Color fundus image; 2212 by 1659 pixels
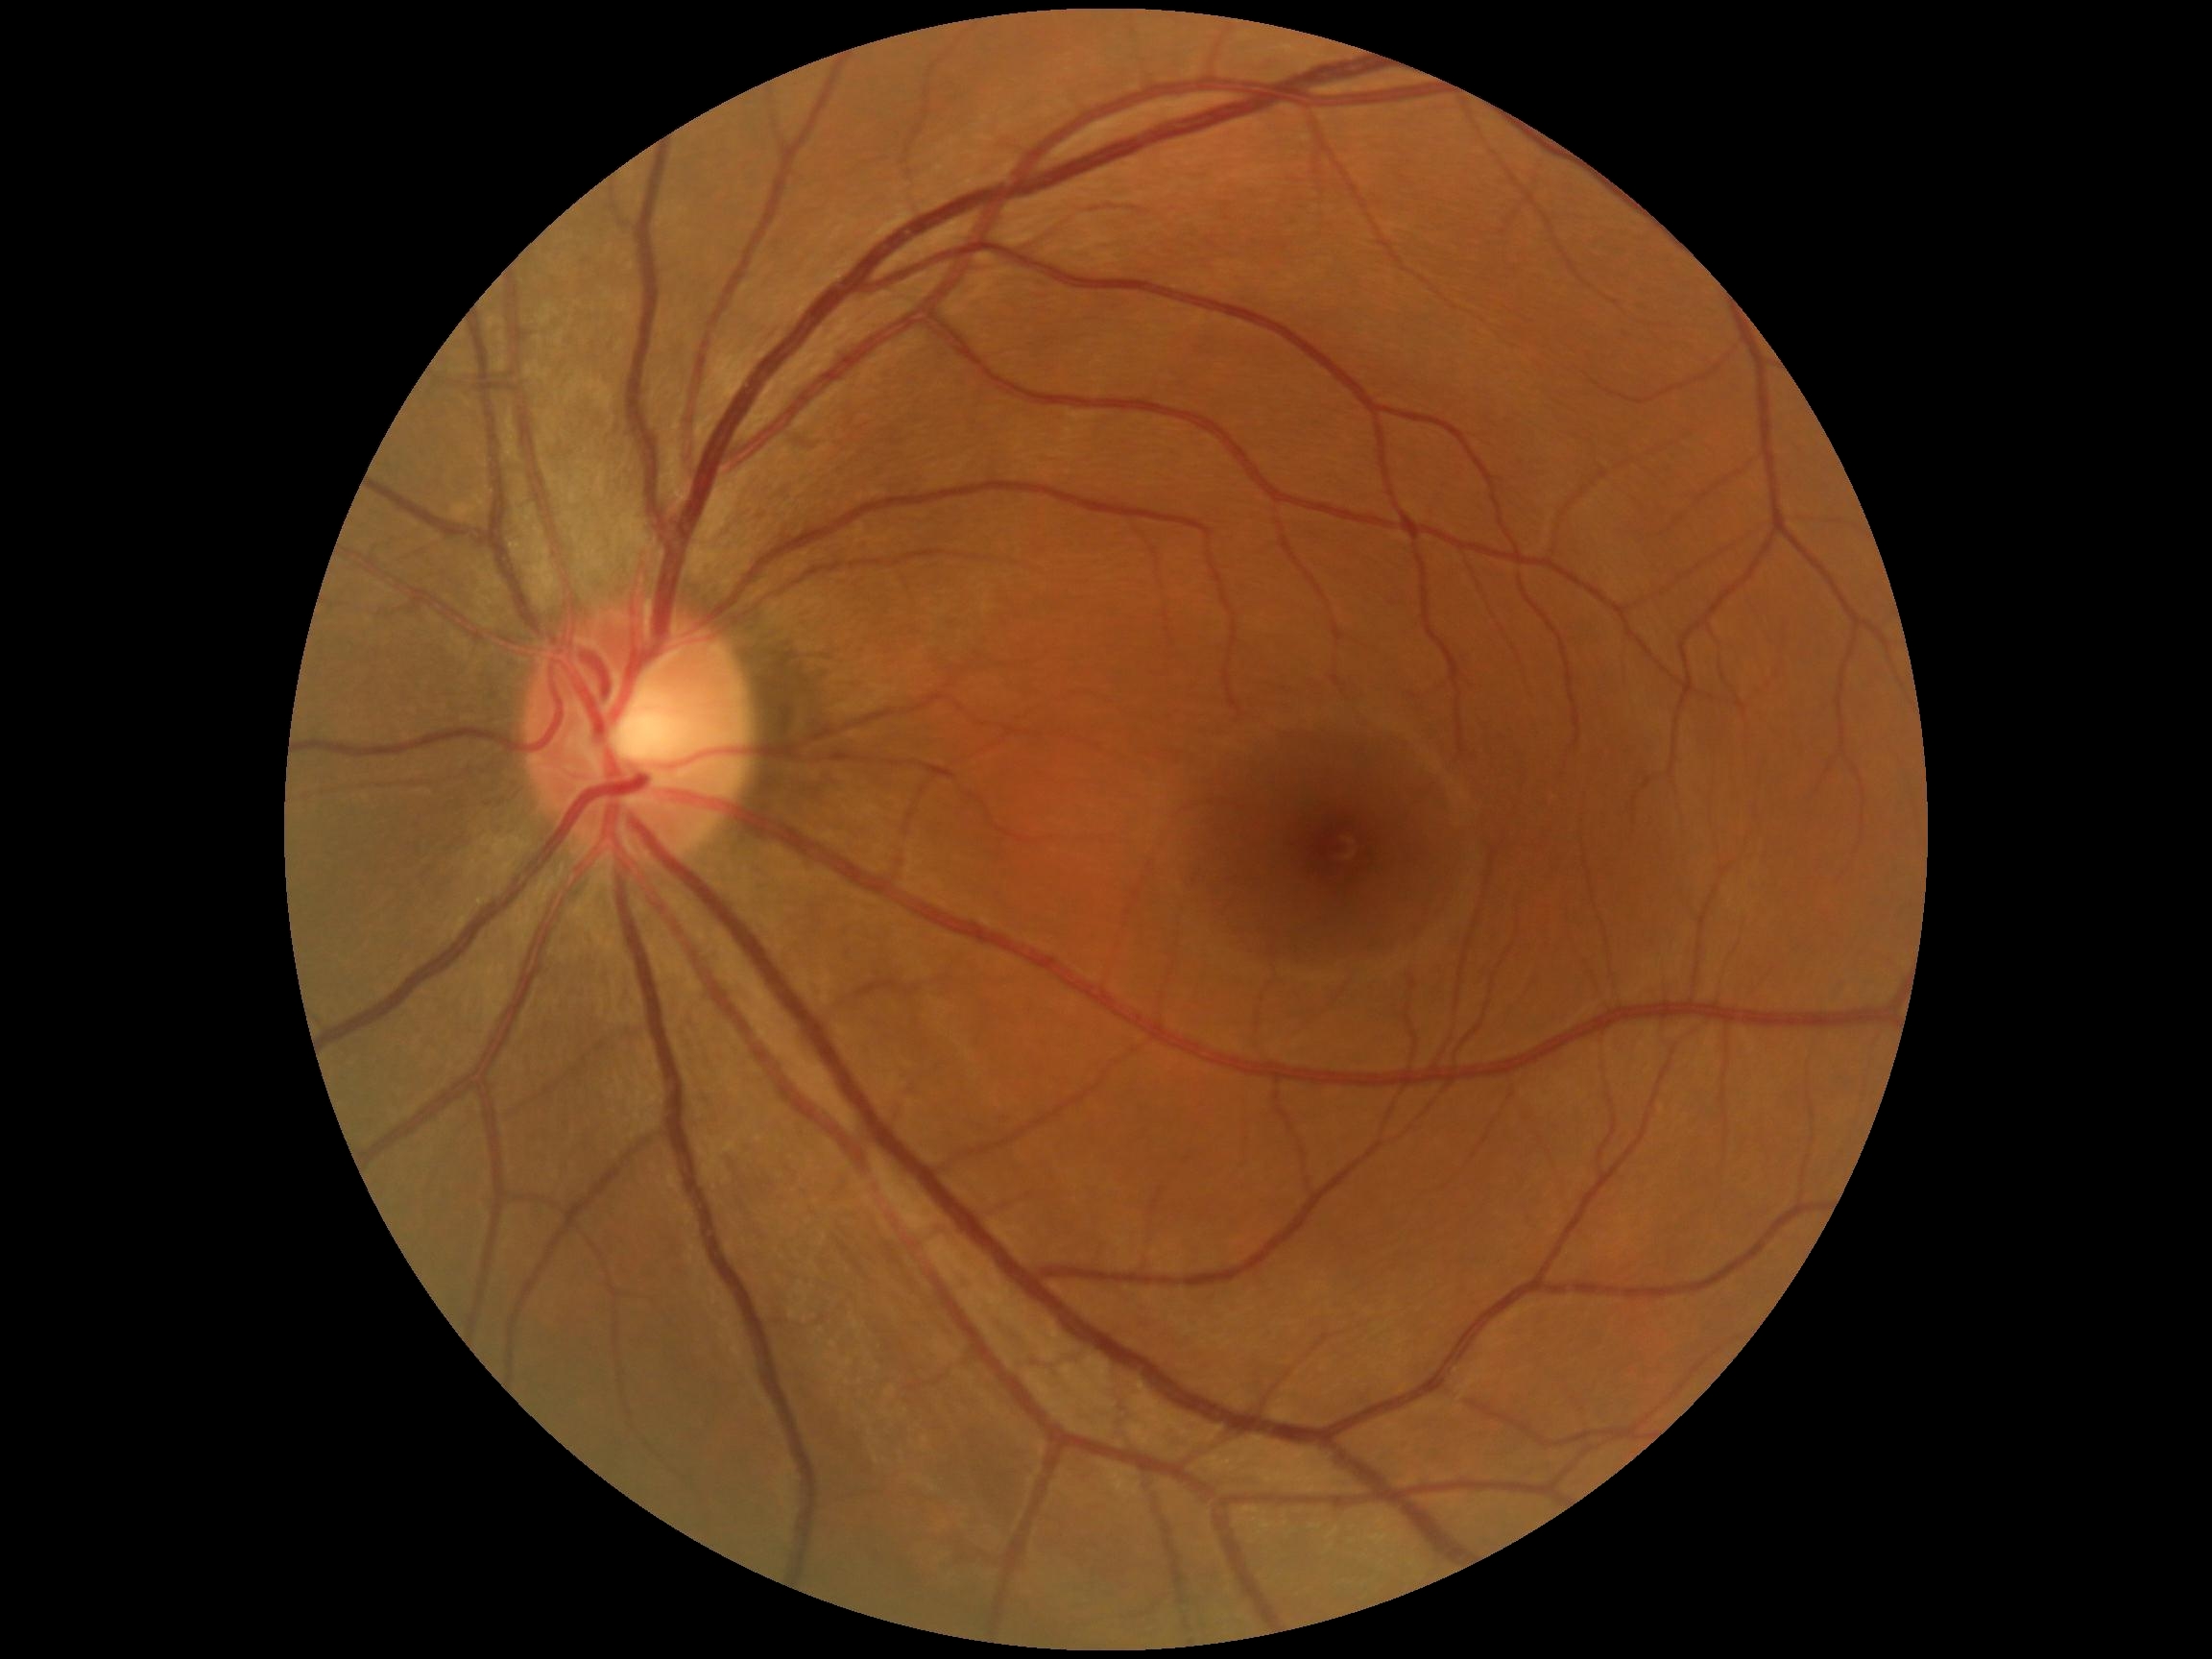

DR impression: no signs of DR | diabetic retinopathy (DR): 0/4.